Refraction: +2.5 -1 x 70; age 72; visual field mean defect (MD): -11.44 dB; woman patient: 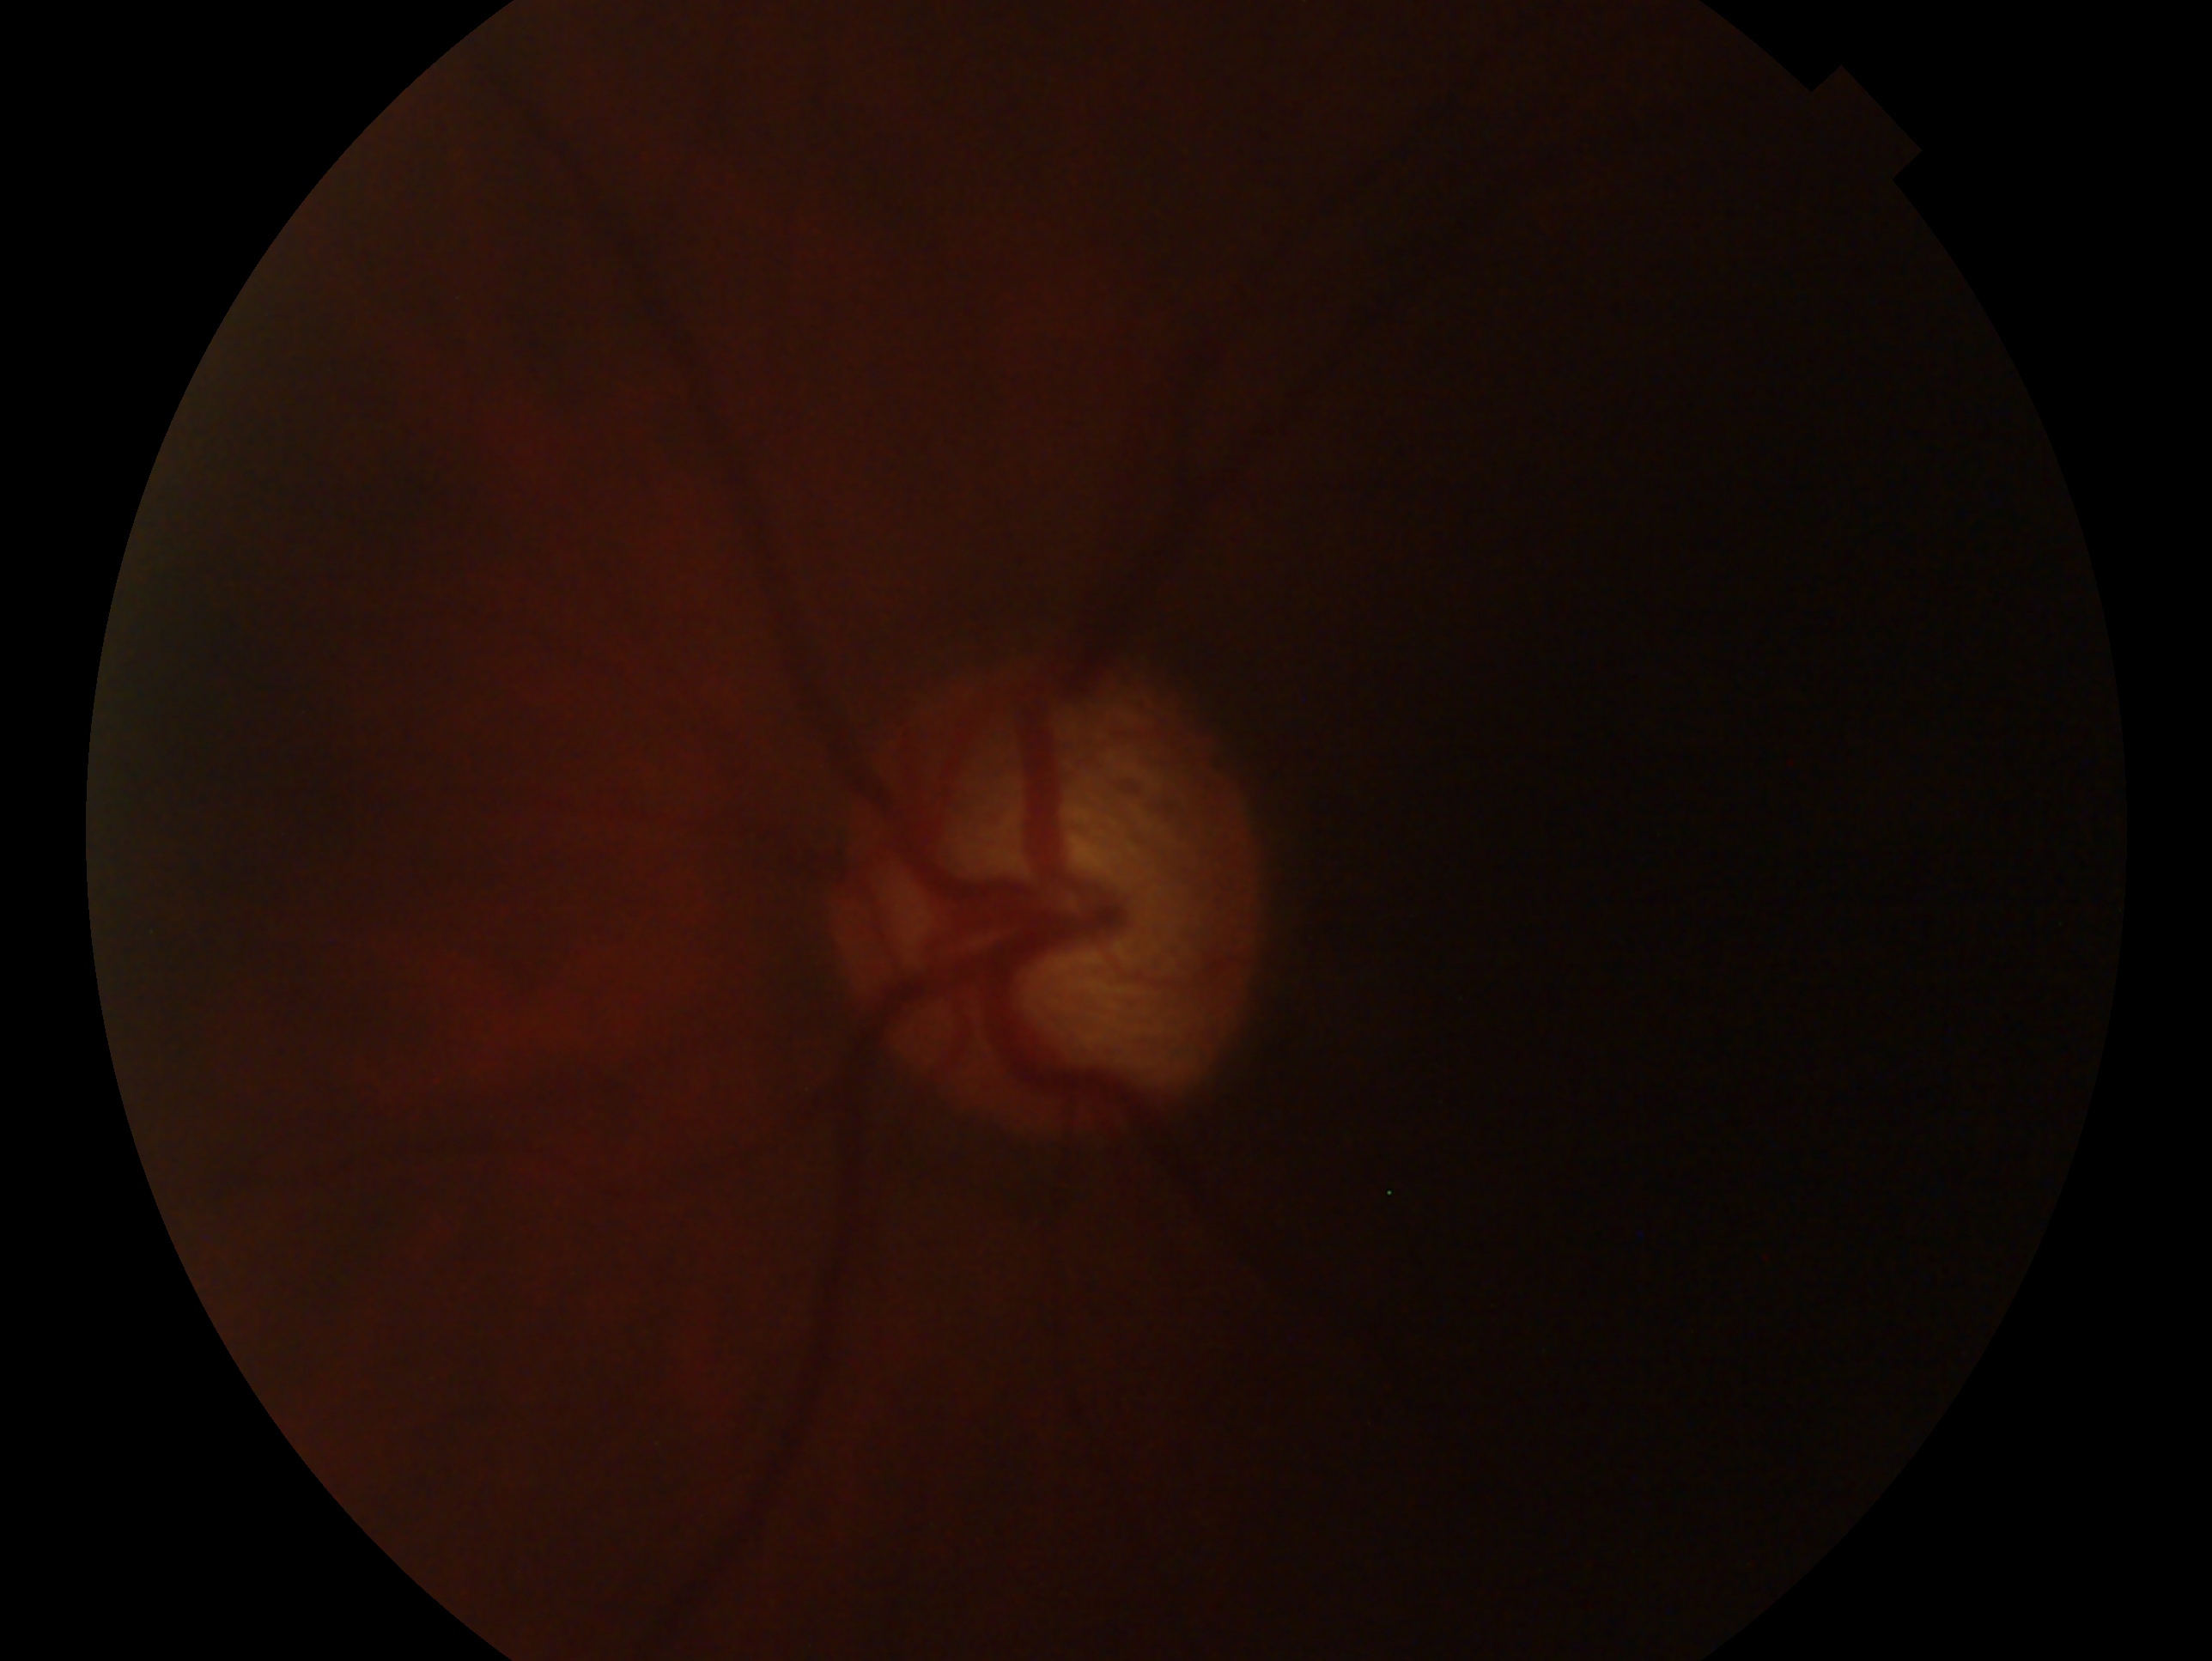 - impression: glaucoma
- laterality: left eye